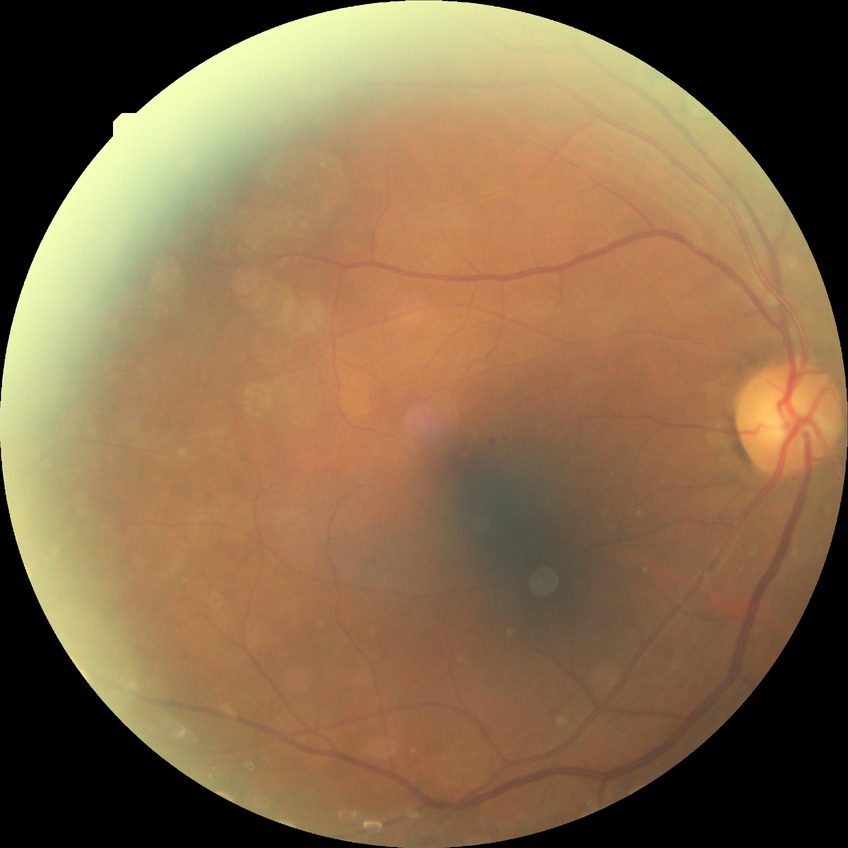 Davis grading is simple diabetic retinopathy.